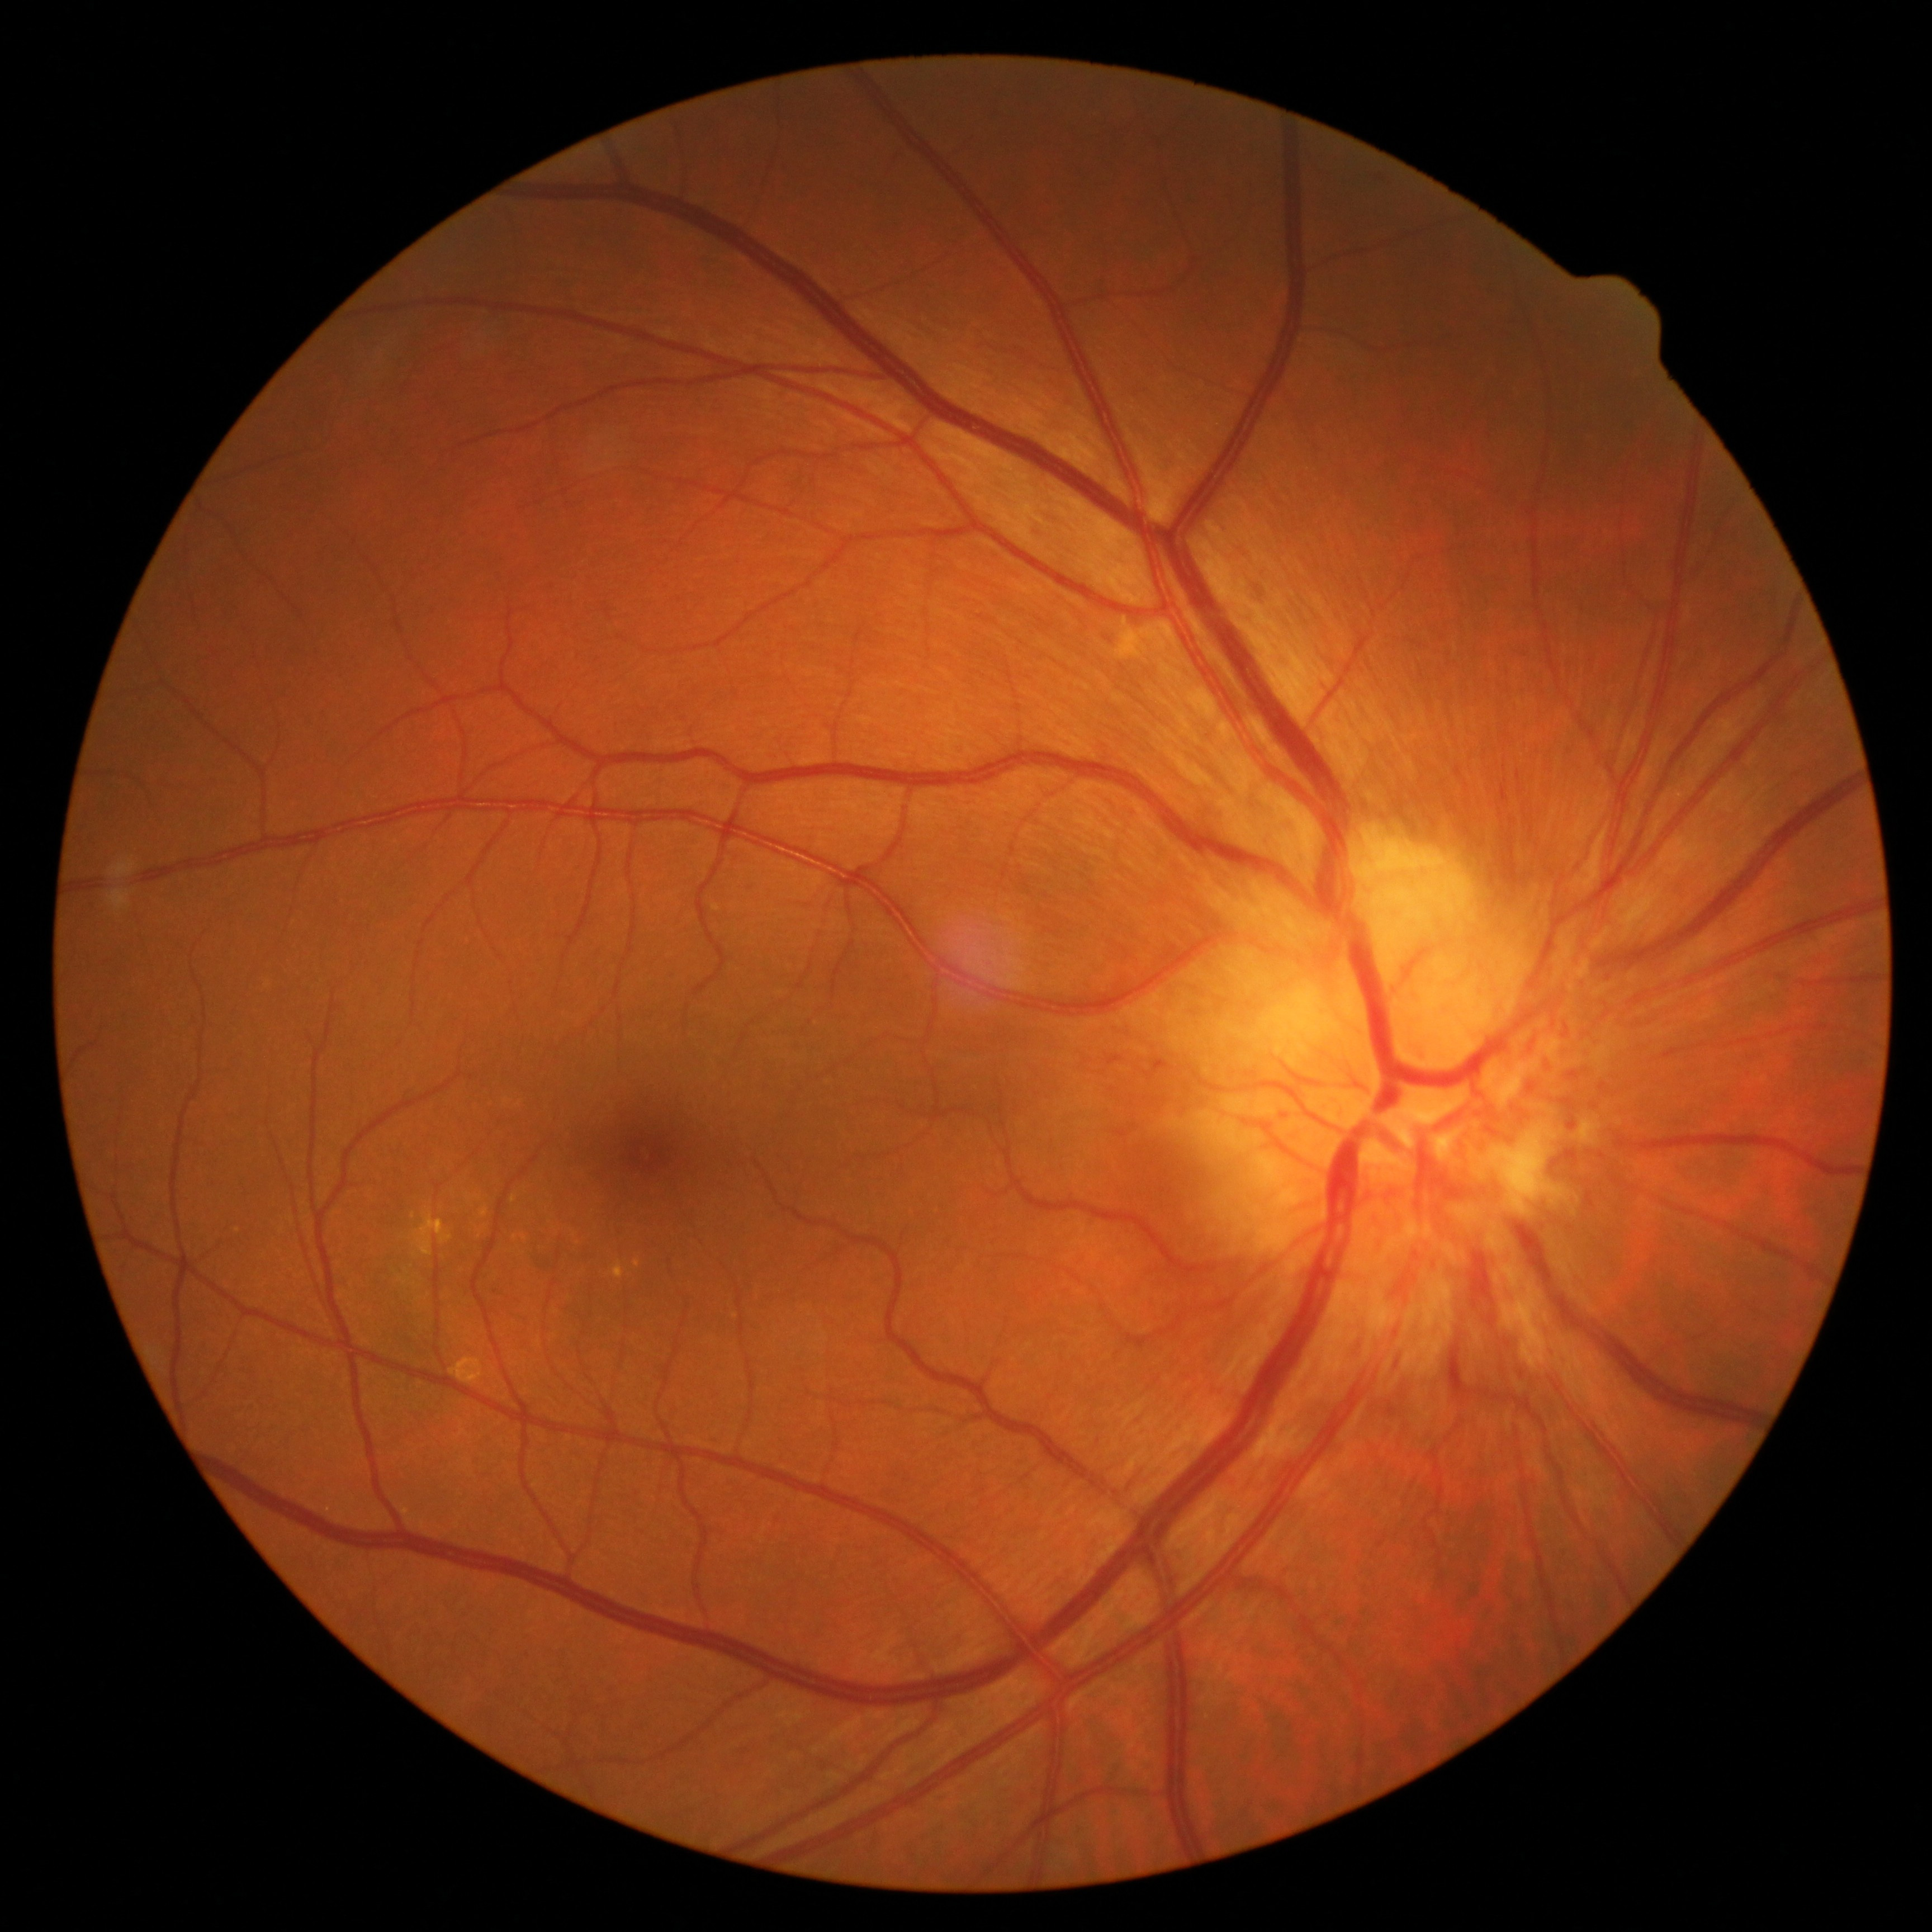

Diabetic retinopathy (DR) is 2.